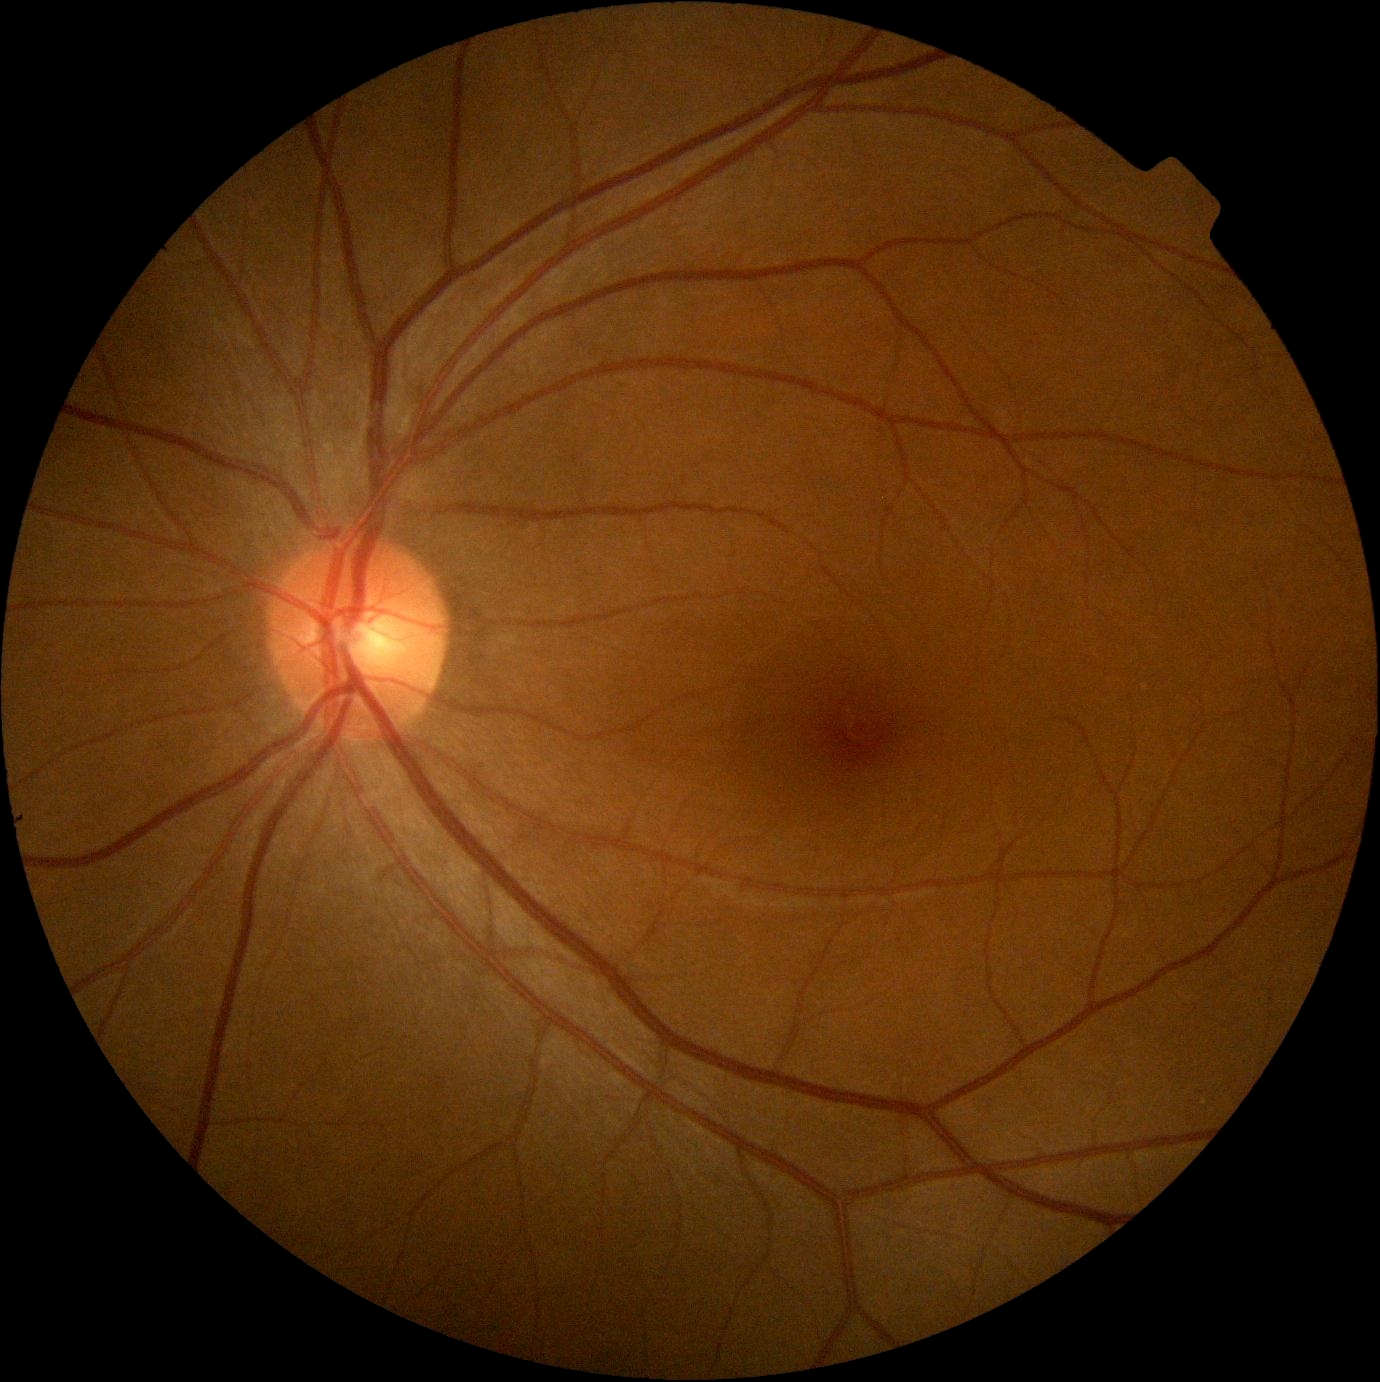

Annotations:
- DR: grade 0 (no apparent retinopathy)